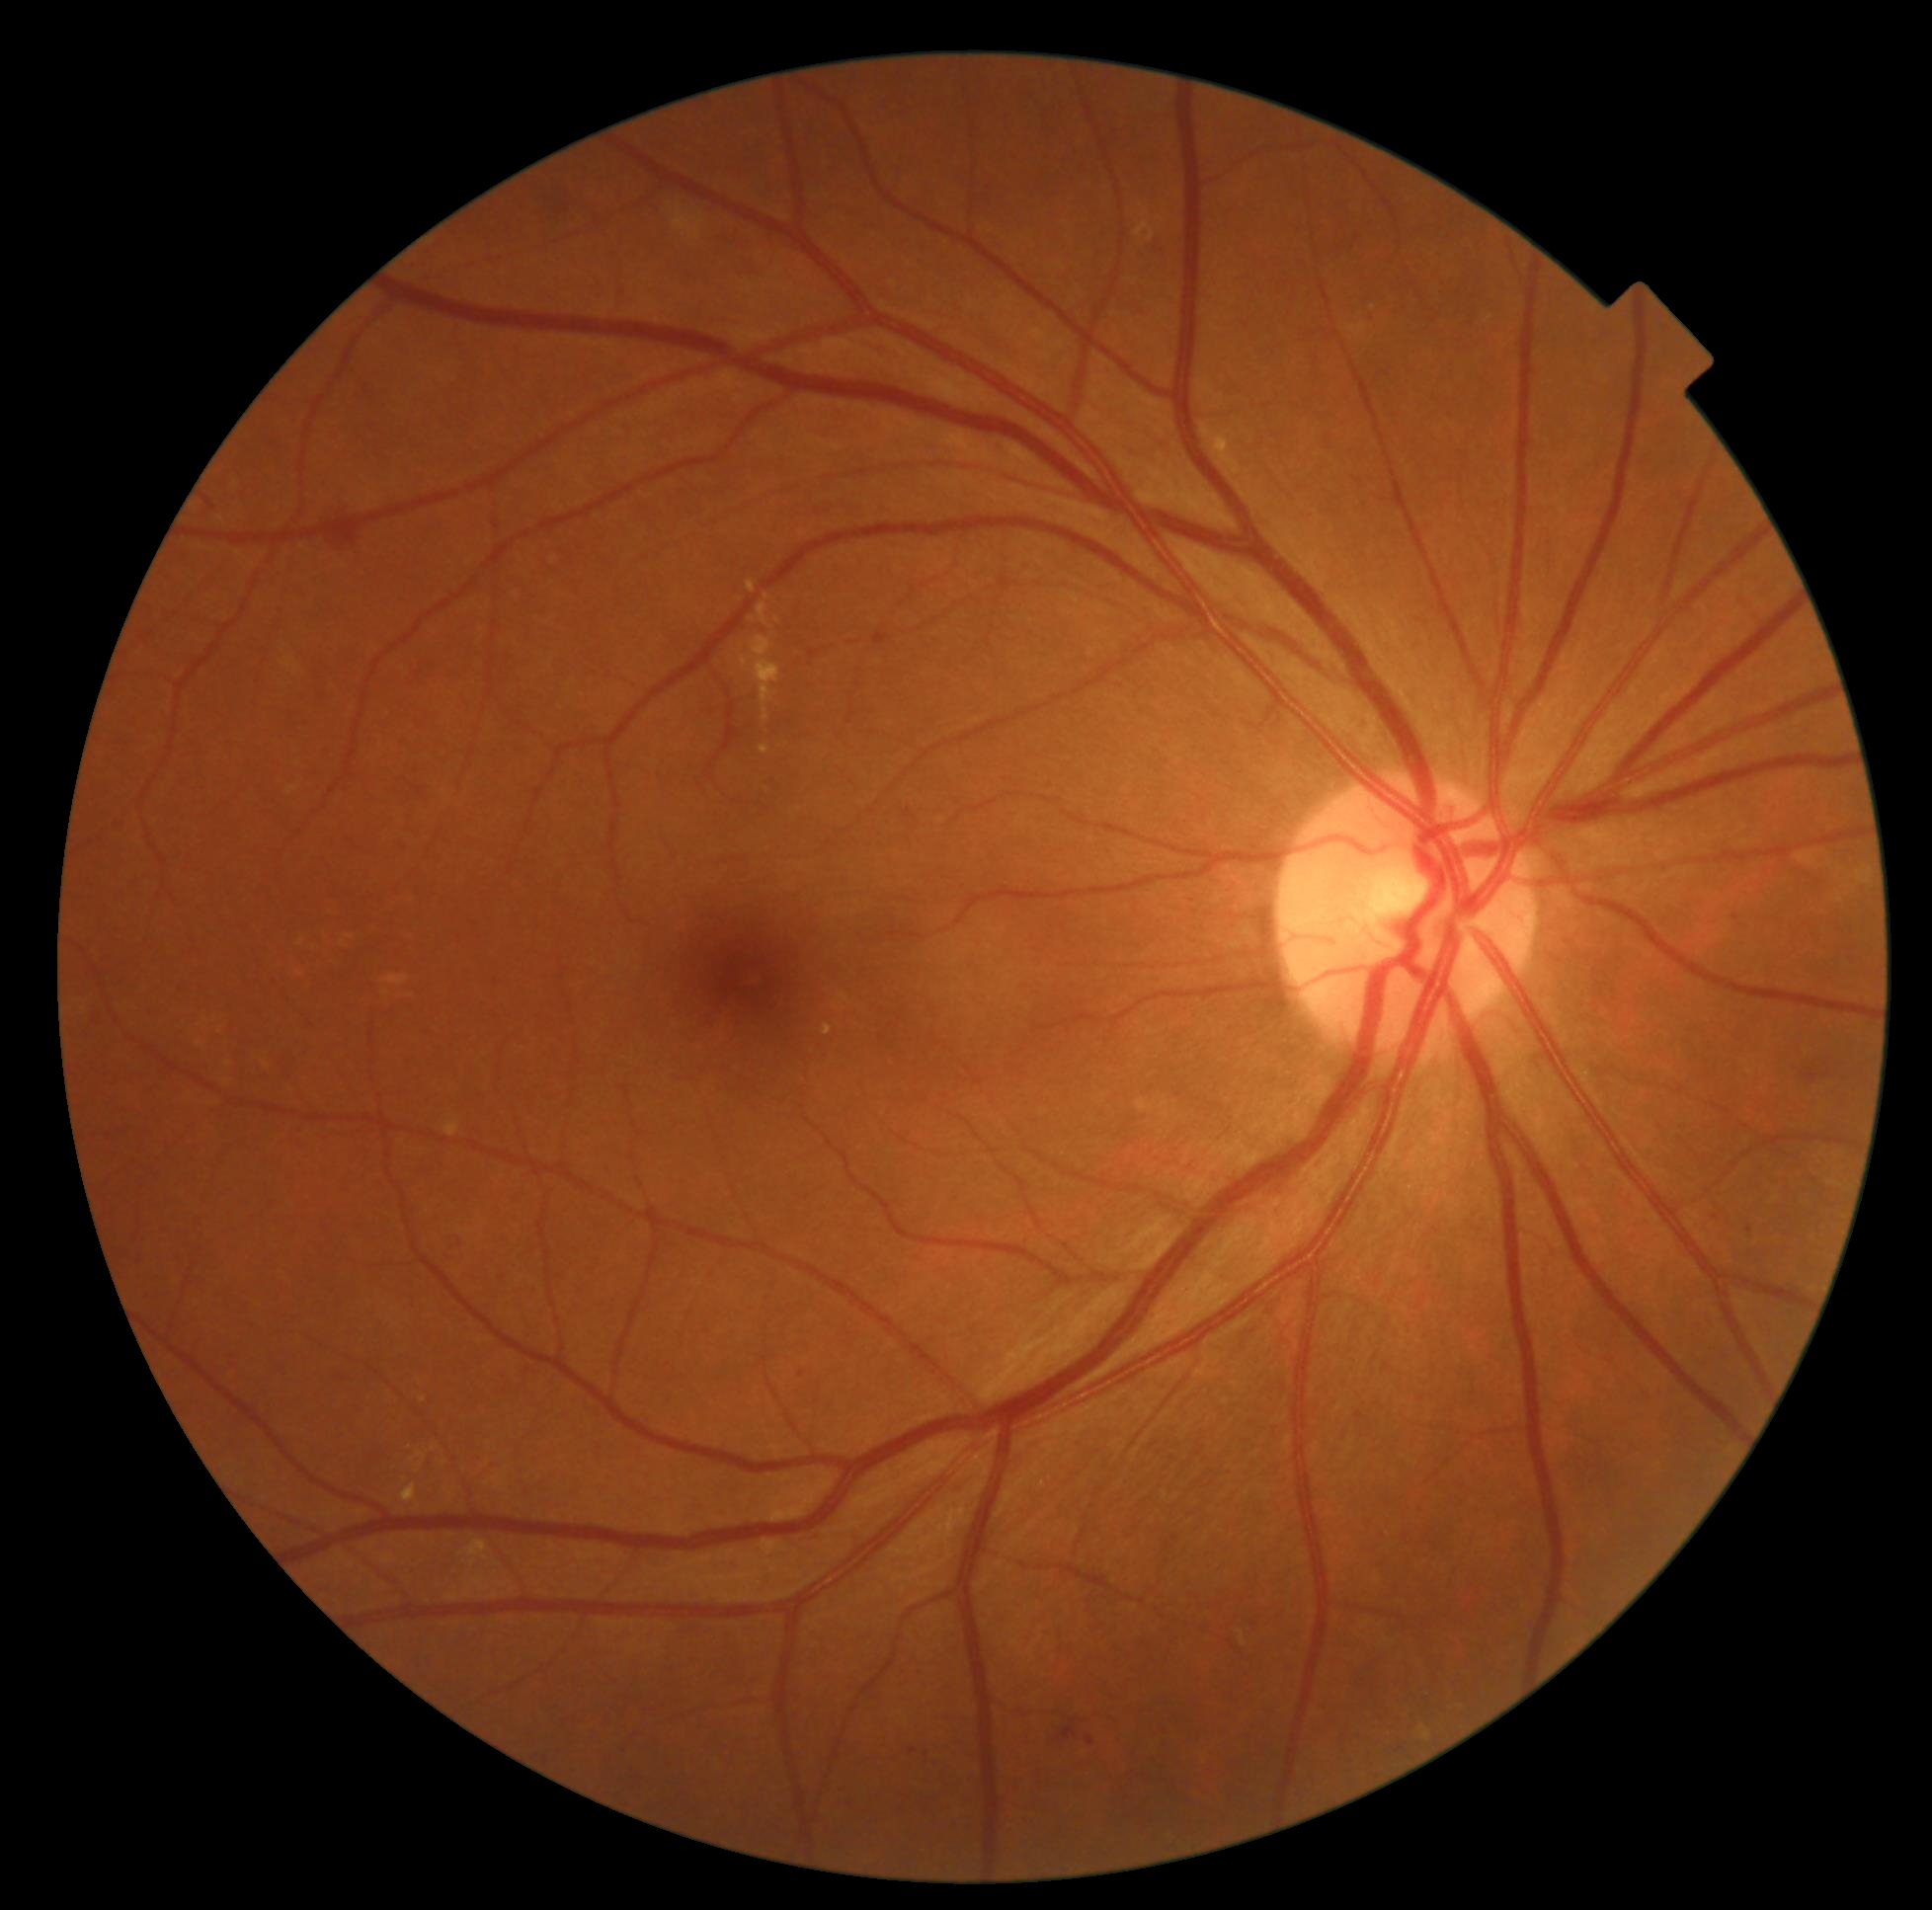 DR class: non-proliferative diabetic retinopathy, diabetic retinopathy grade: 2 (moderate NPDR) — more than just microaneurysms but less than severe NPDR.